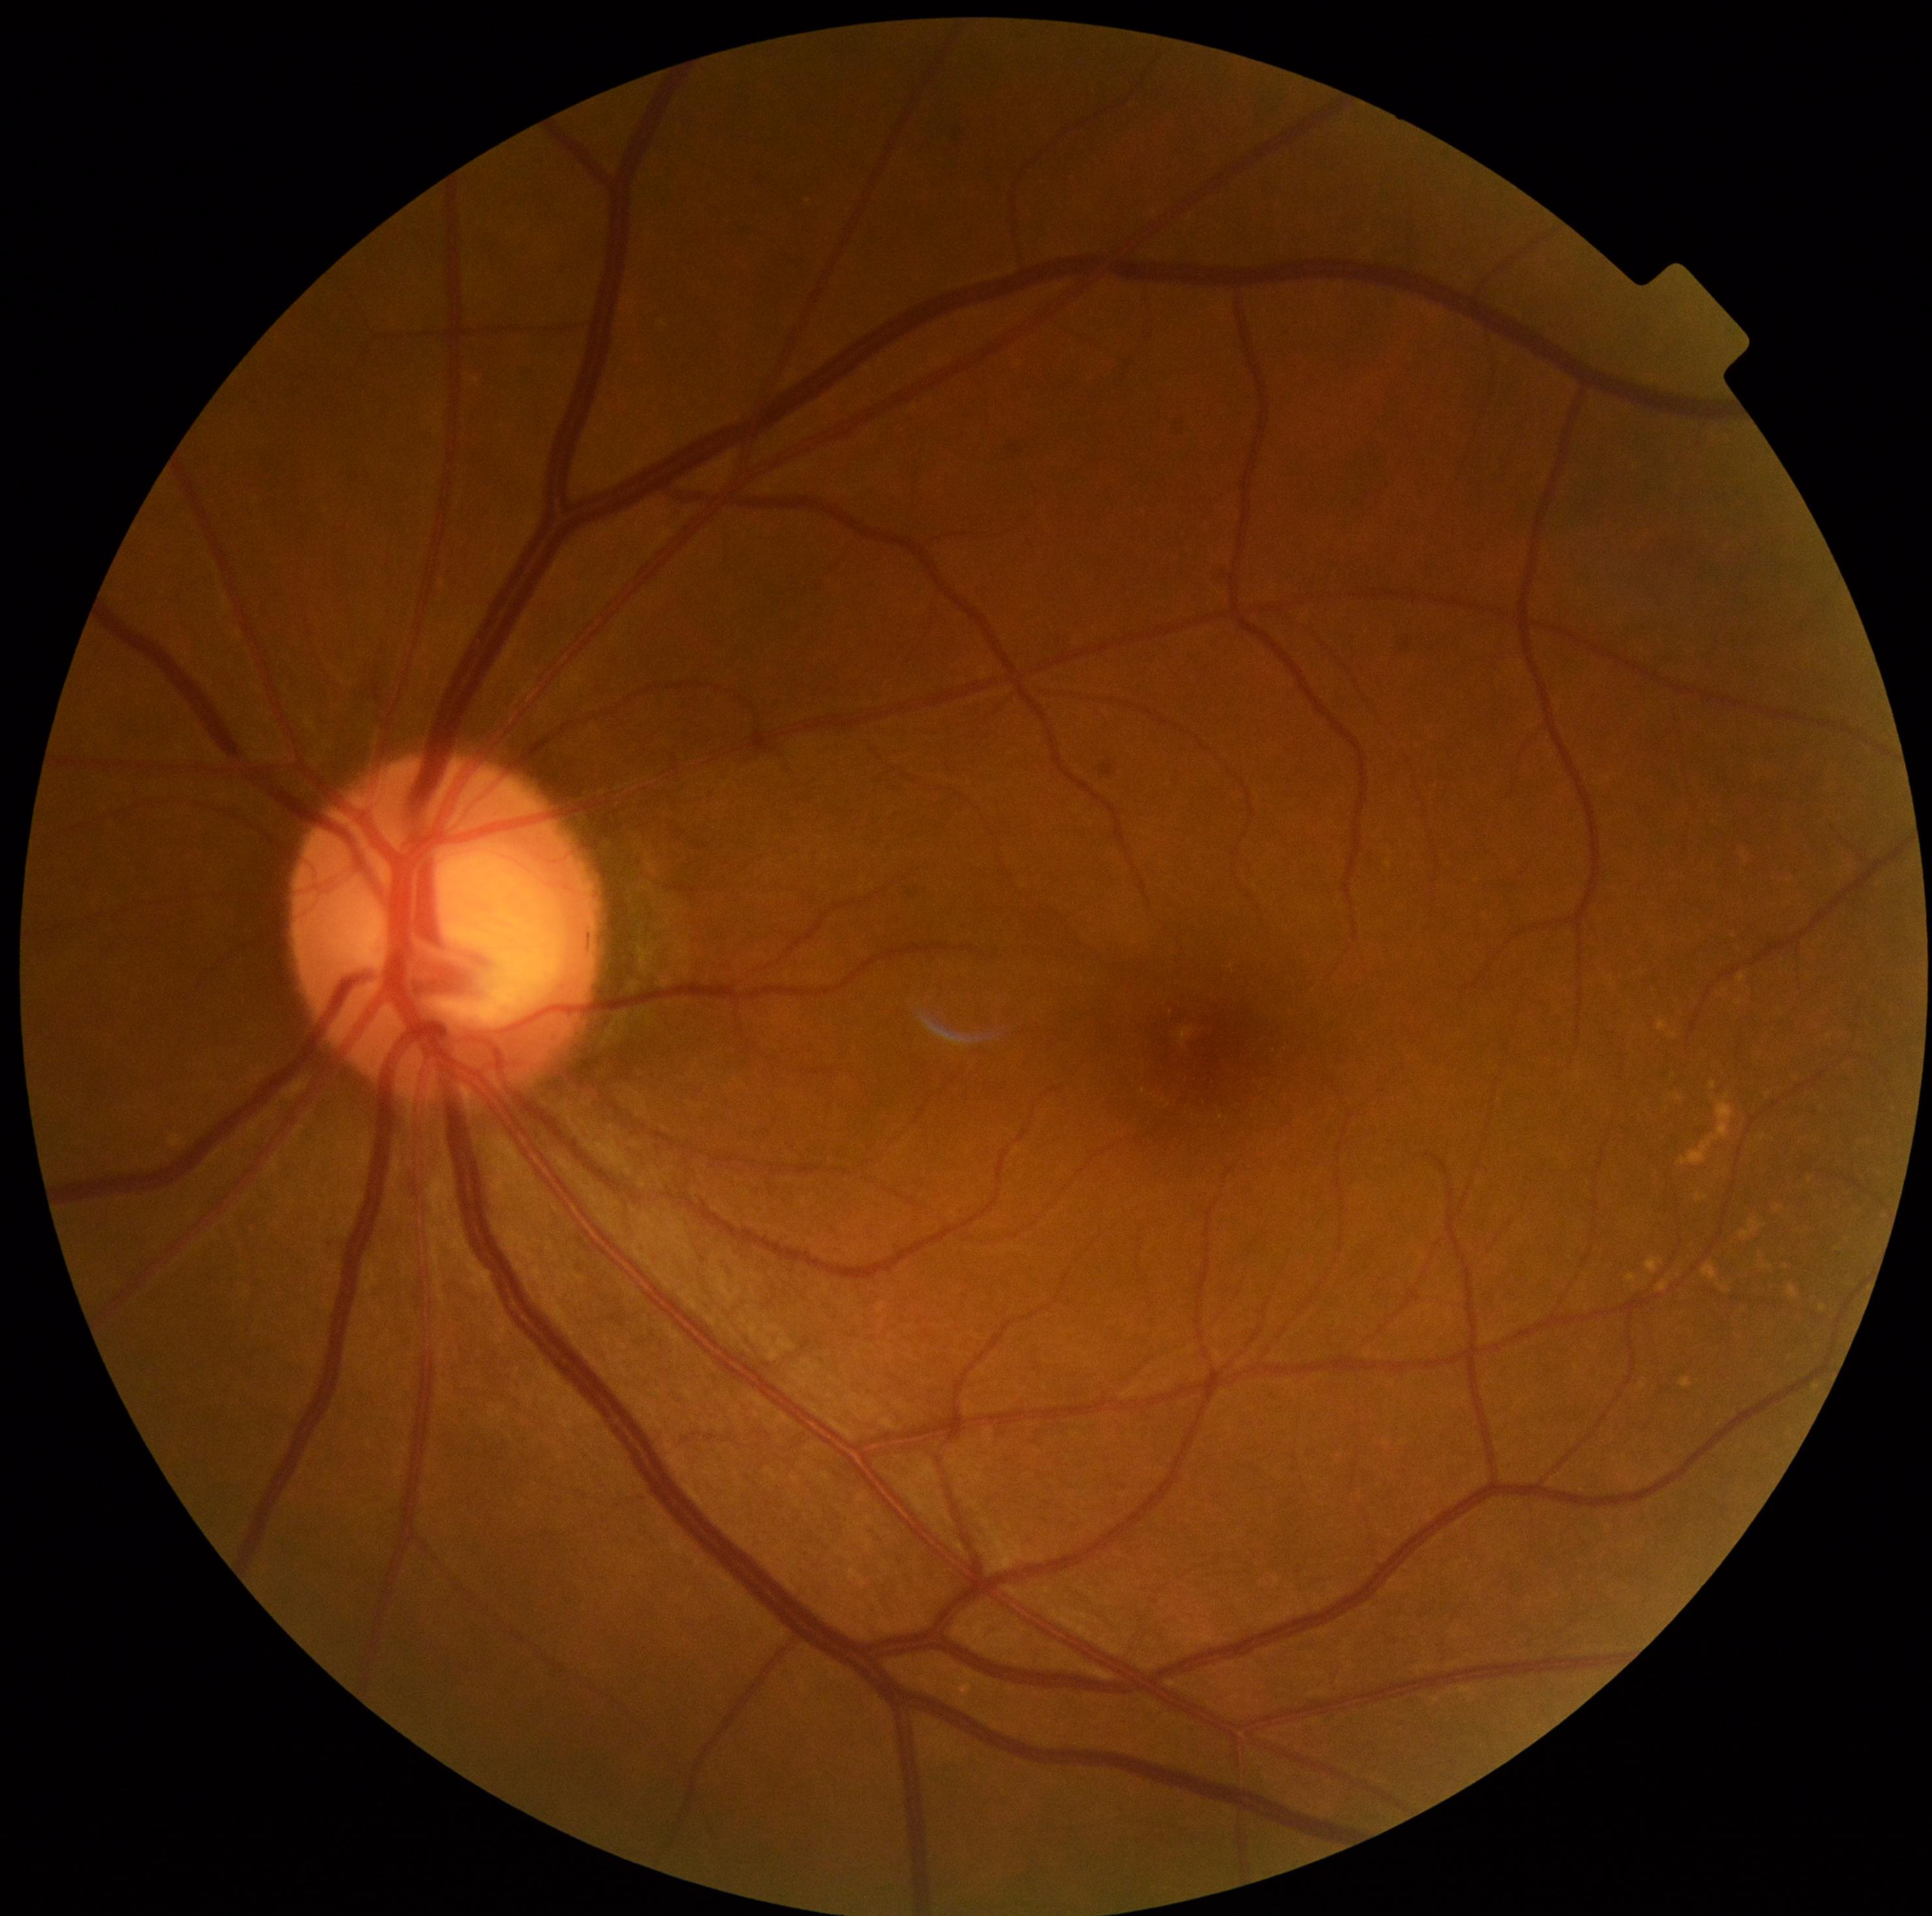

DR severity: grade 0 (no apparent retinopathy), DR impression: no DR findings.